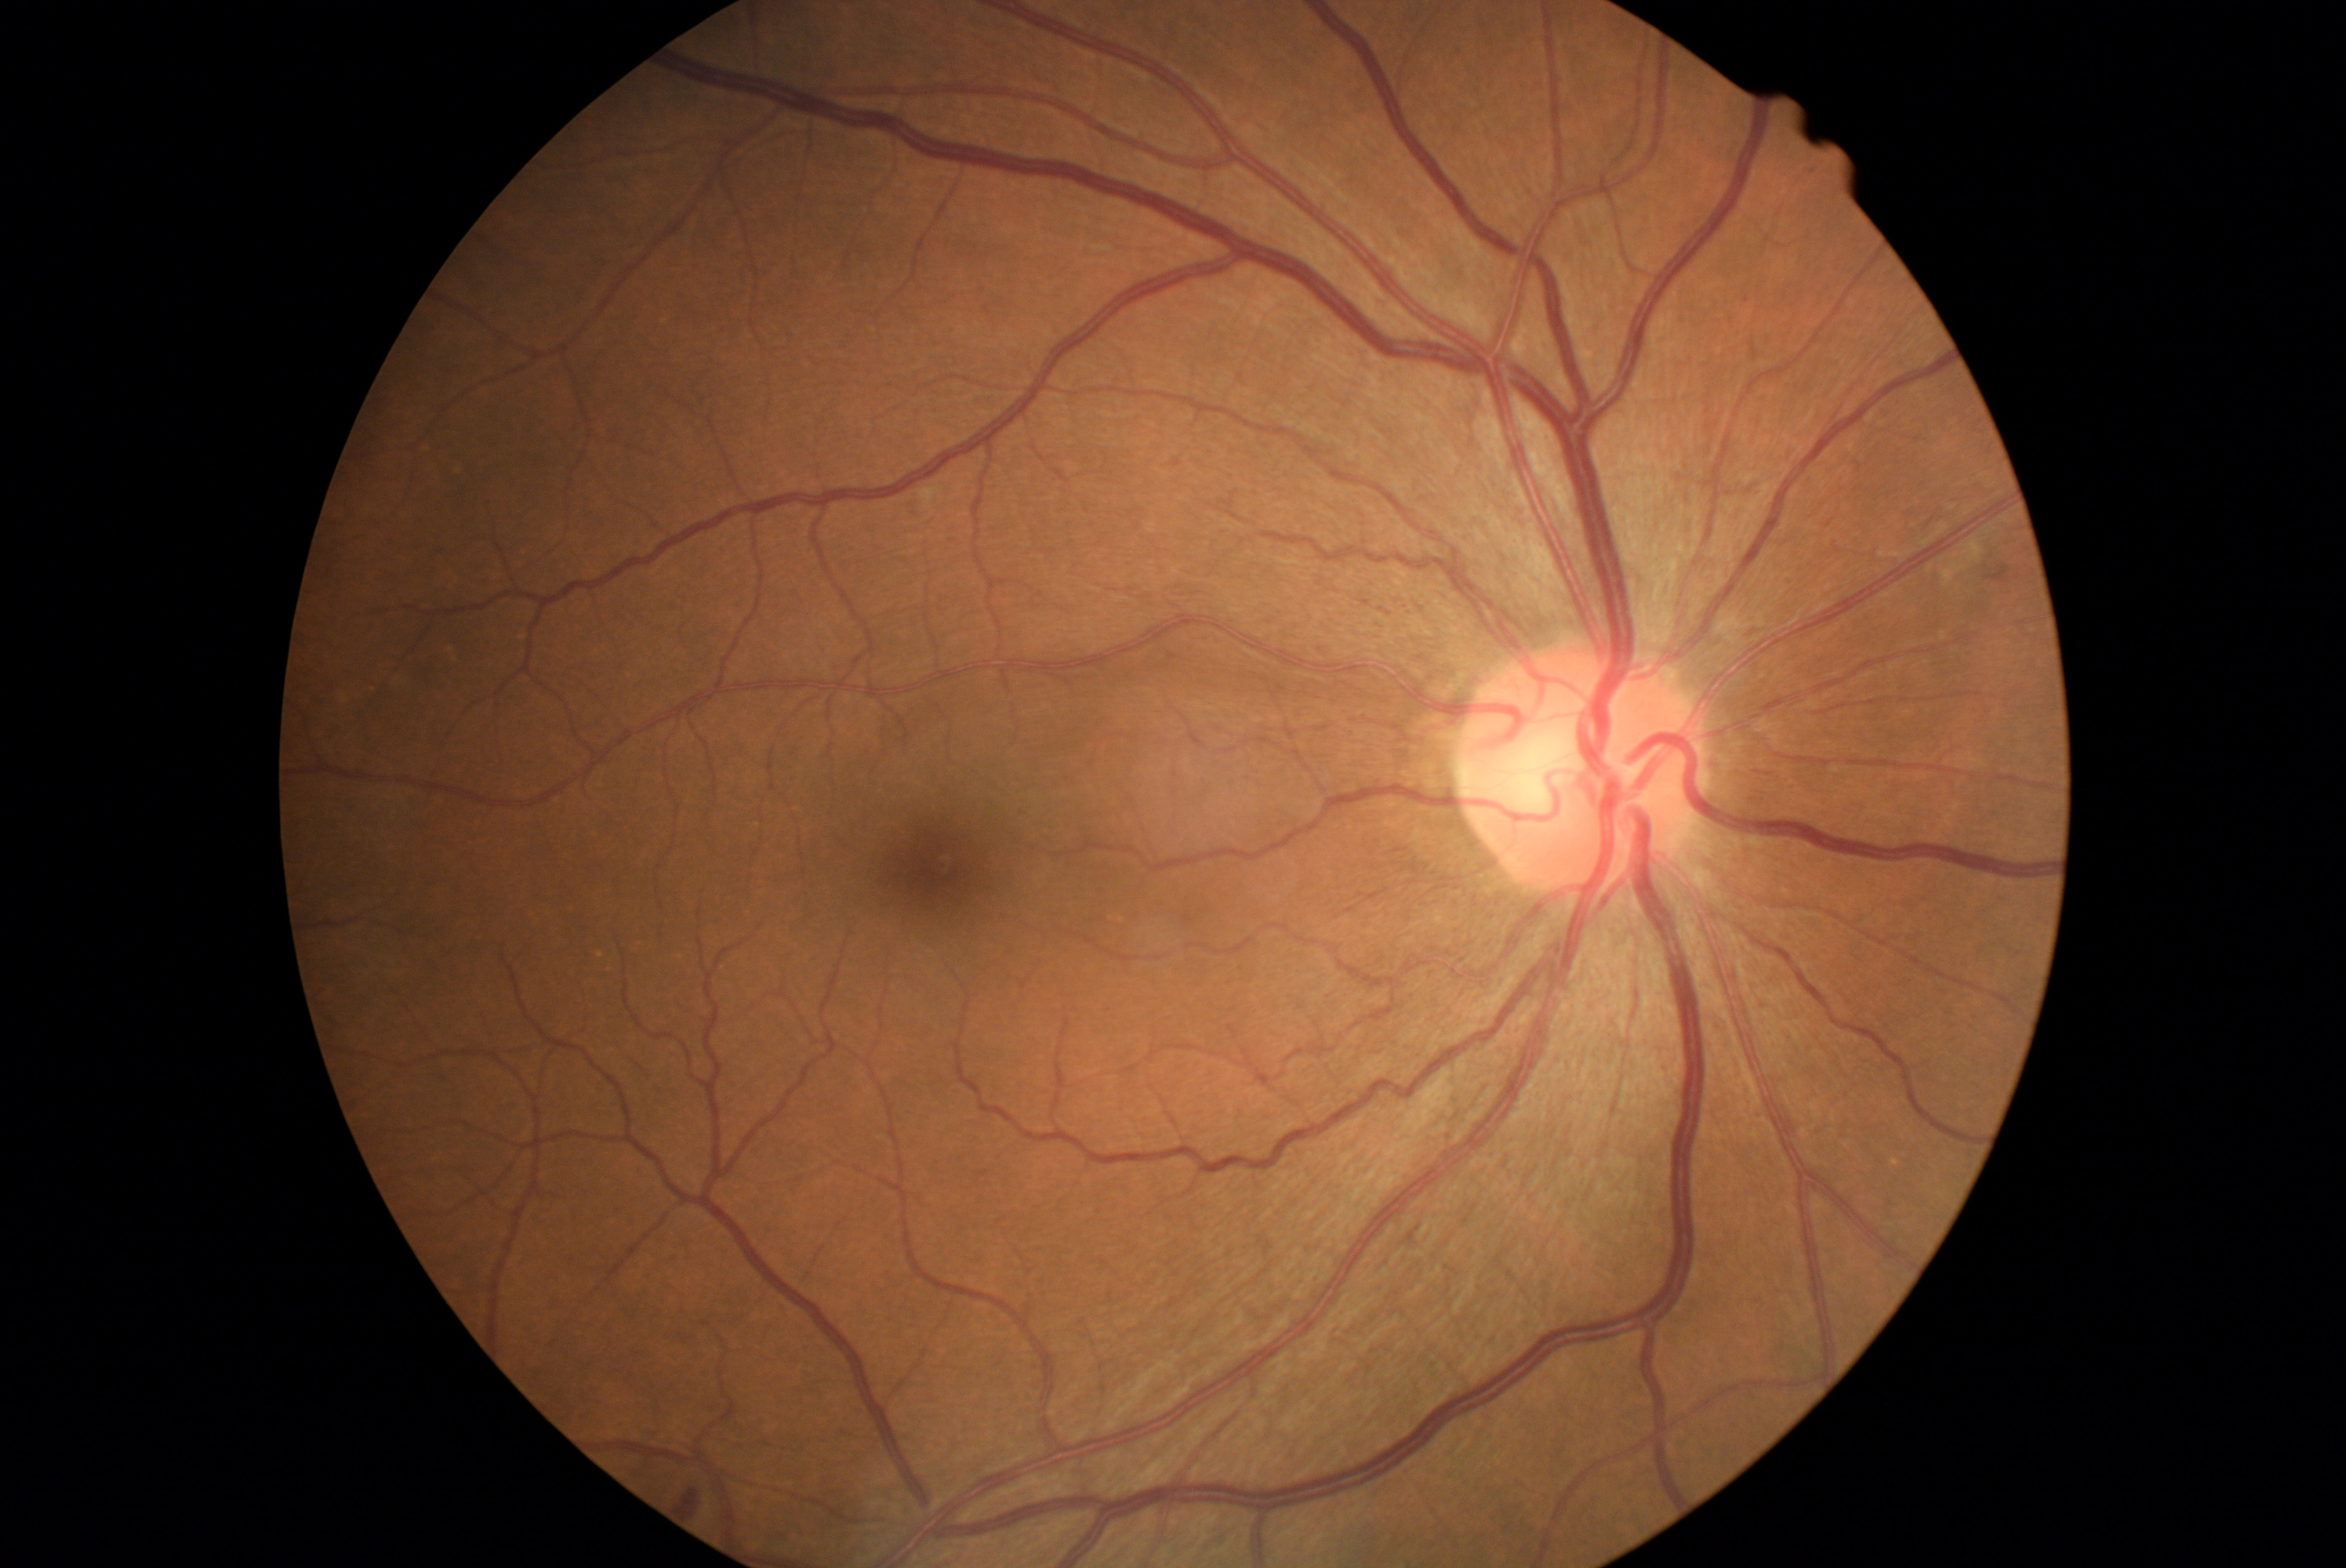
DR class@non-proliferative diabetic retinopathy, diabetic retinopathy (DR)@grade 2.